2352 by 1568 pixels, retinal fundus photograph — 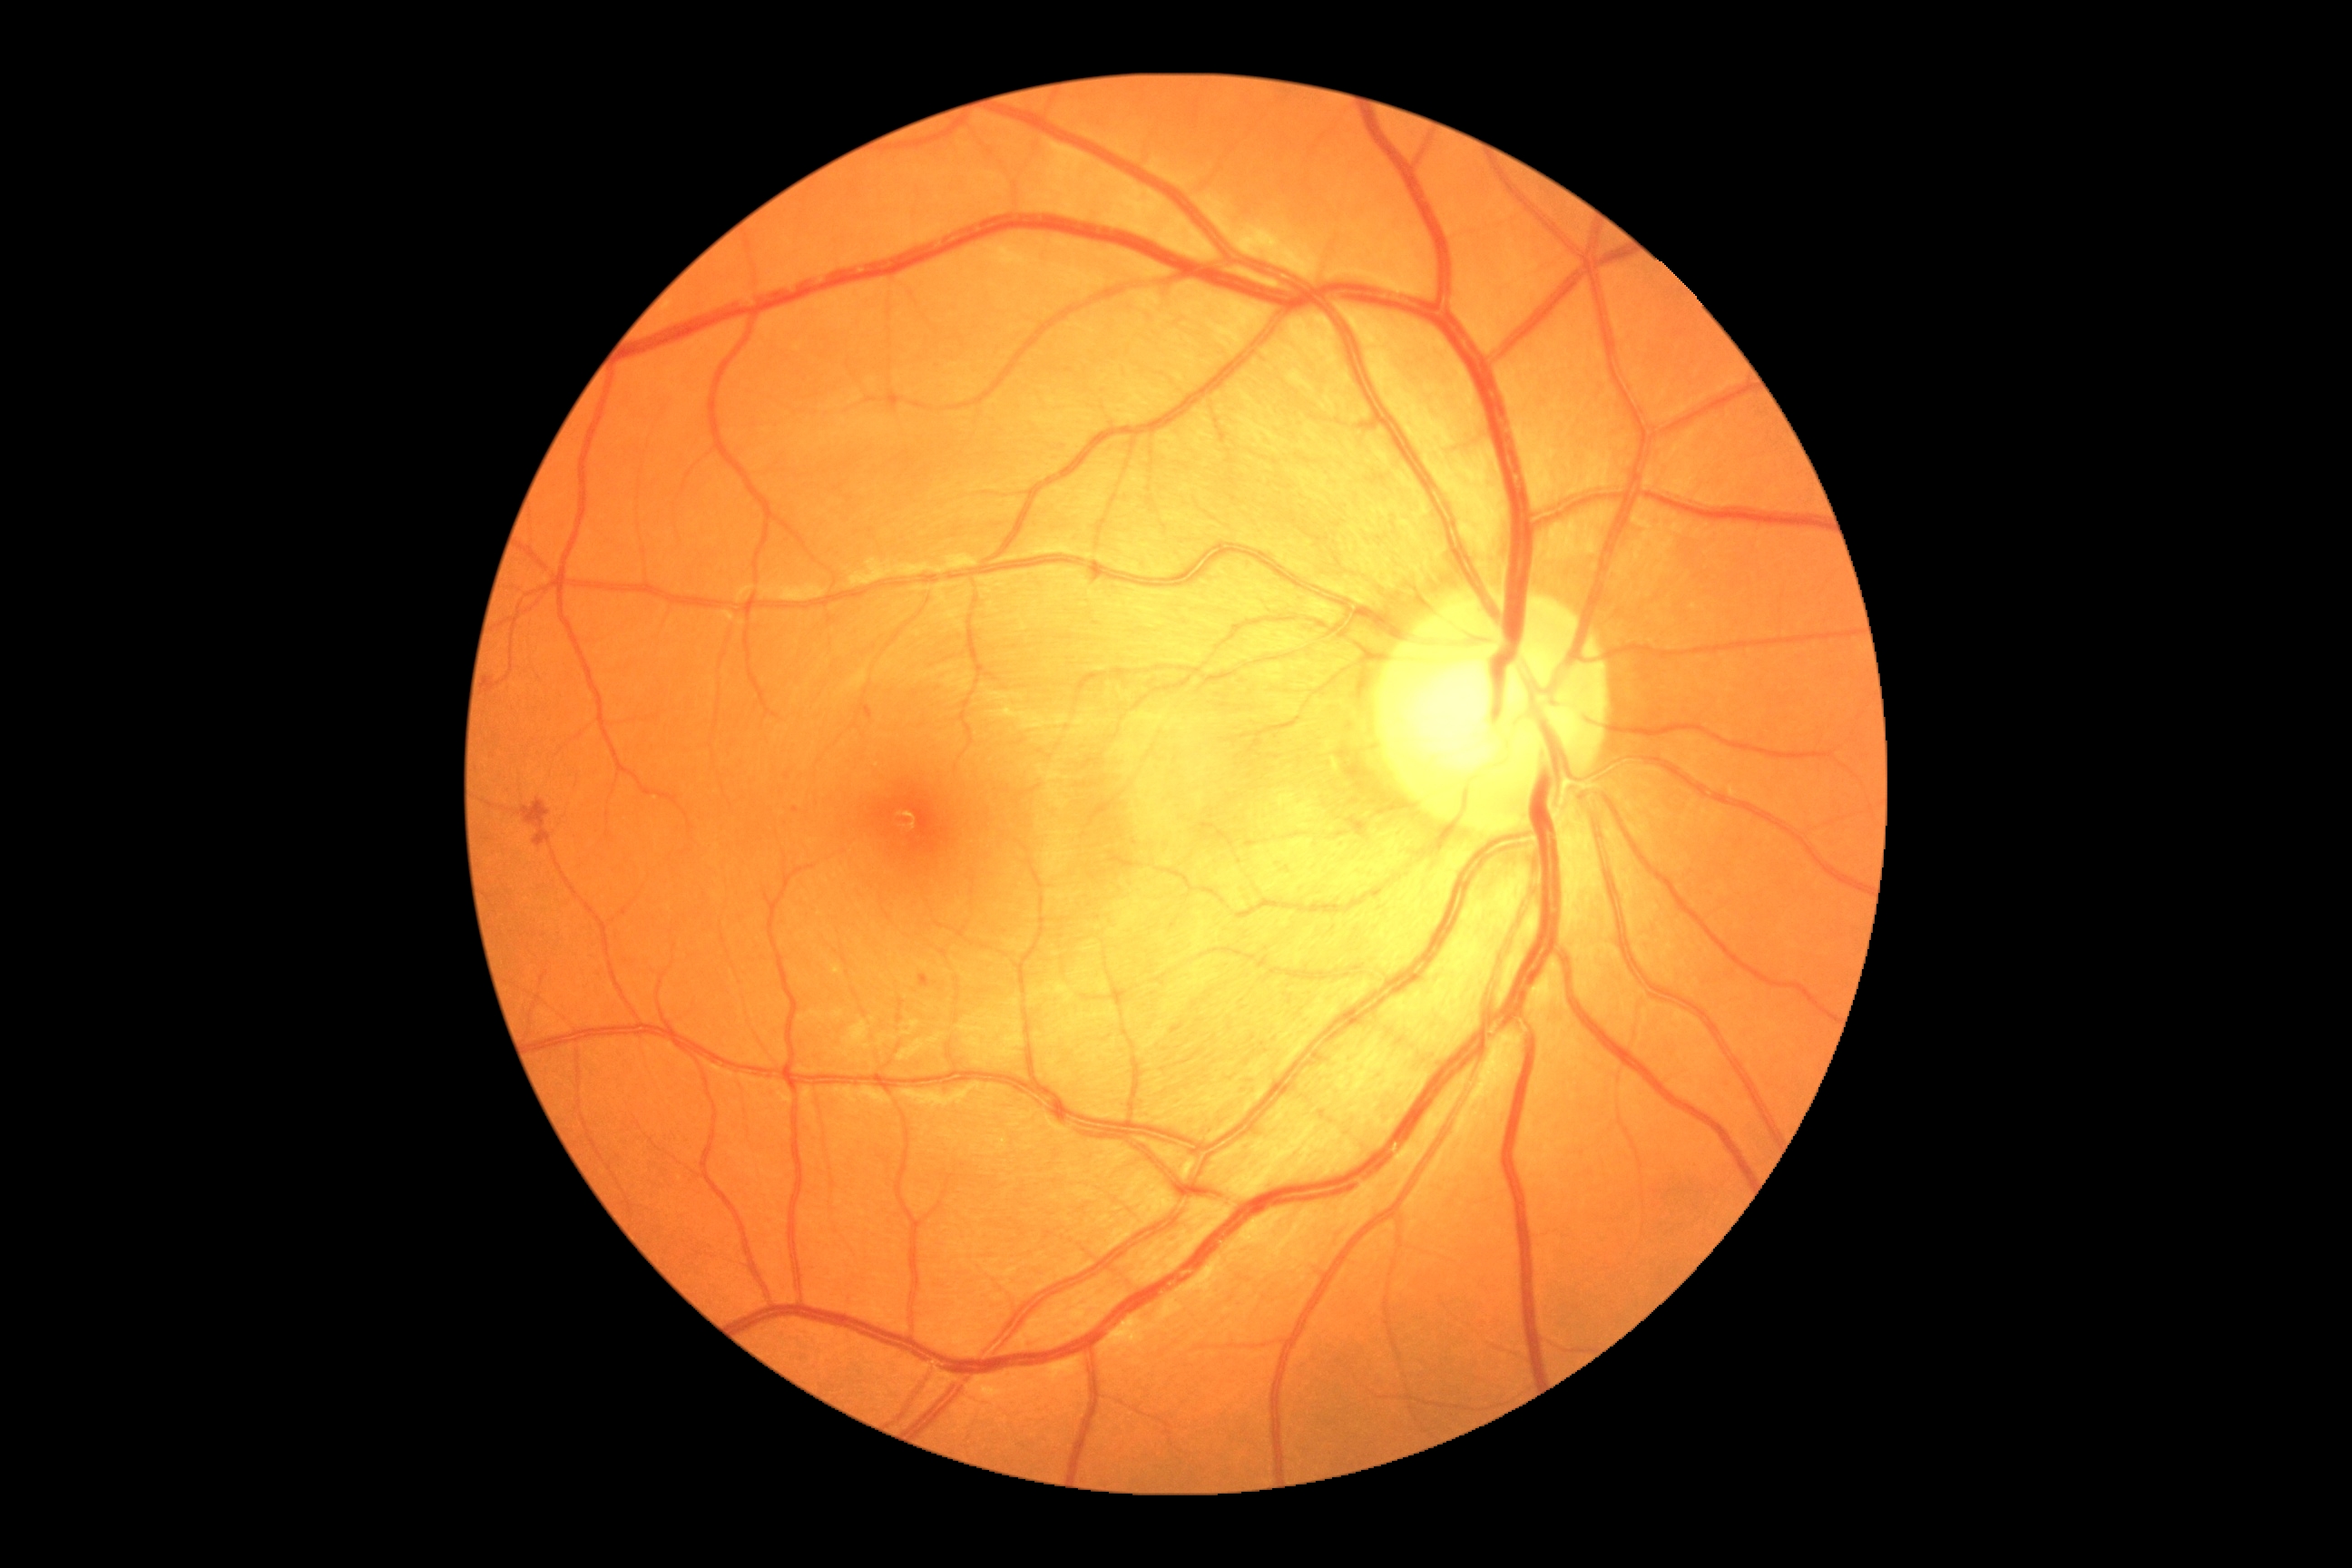 * diabetic retinopathy grade: 2